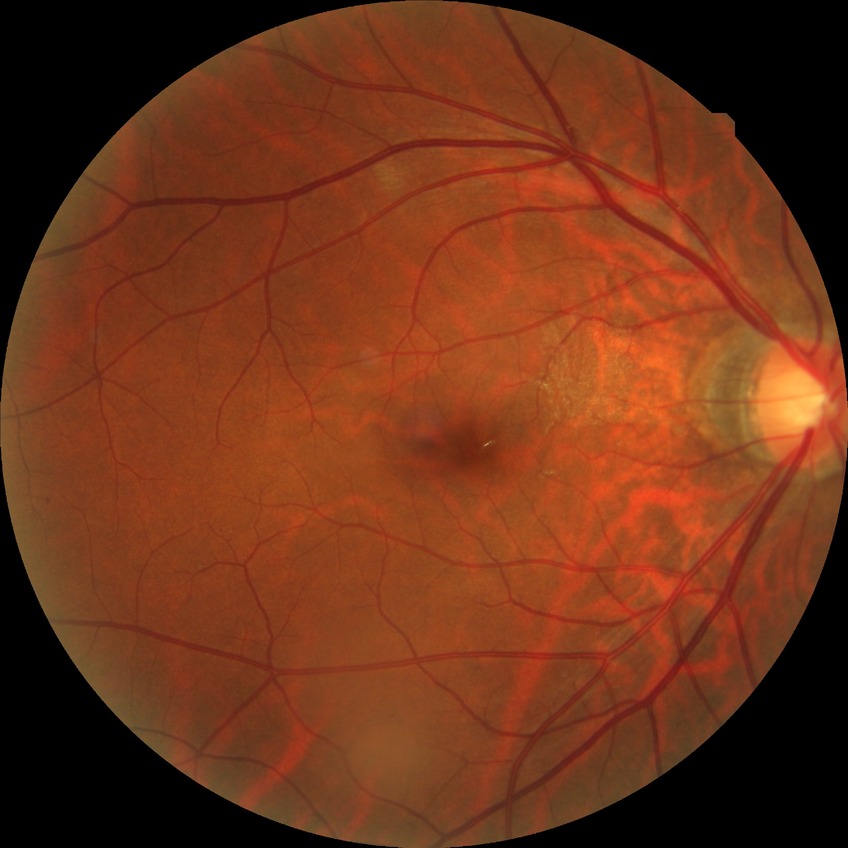

DR severity is NDR. No DR findings.